45° FOV; 2048x1536 — 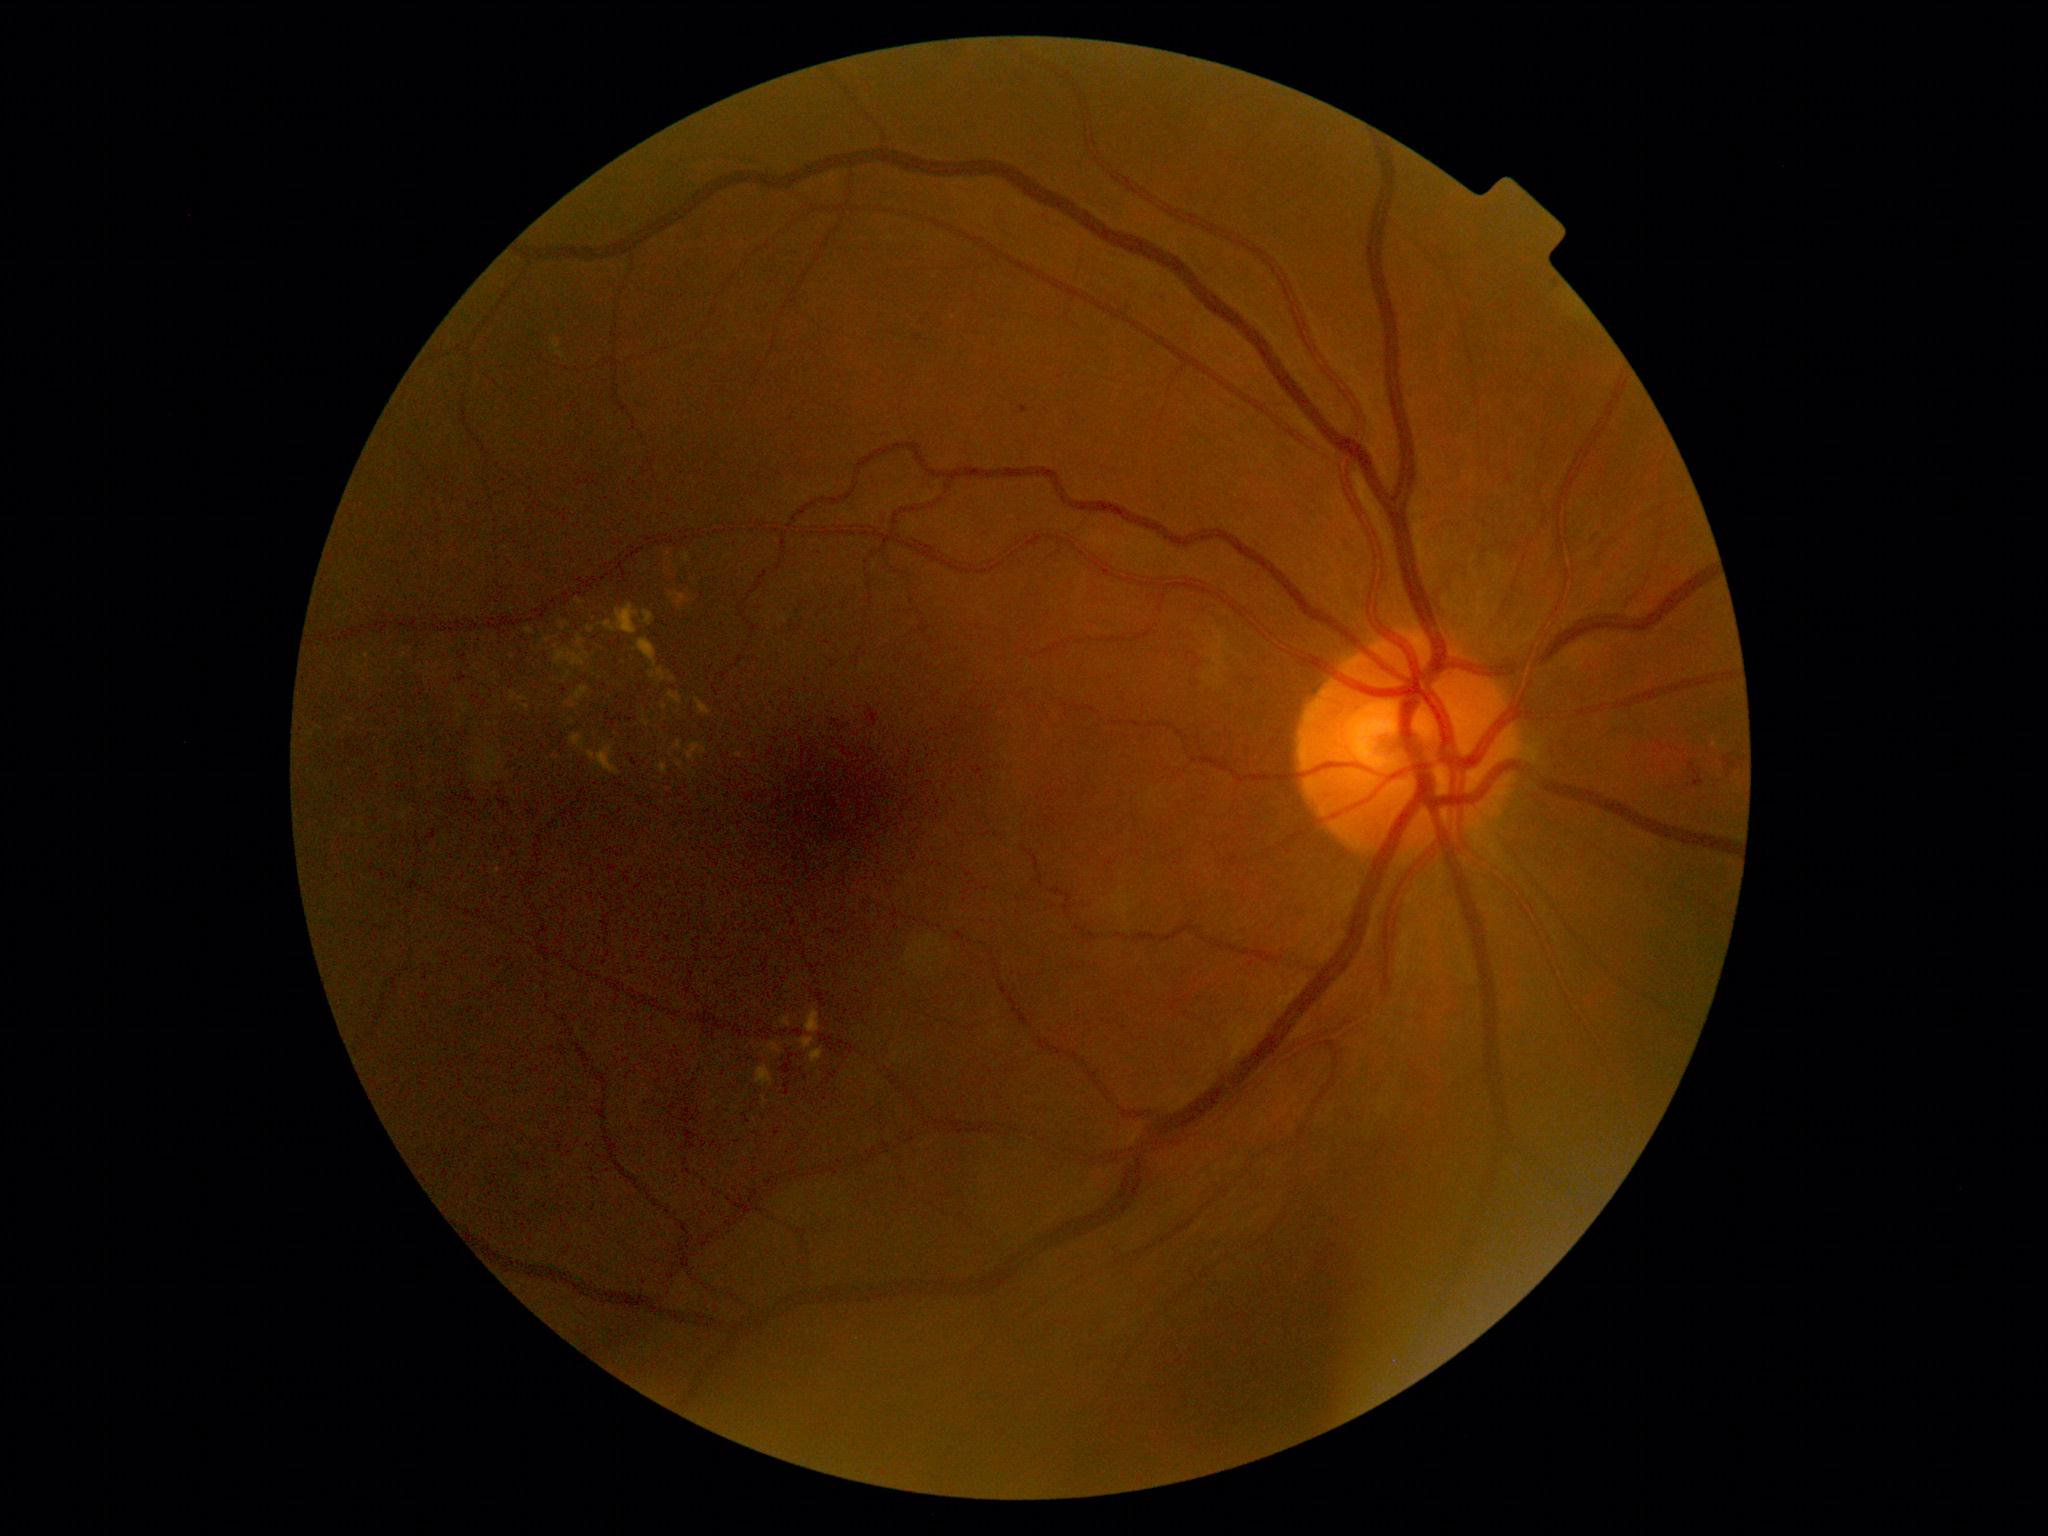 Diabetic retinopathy (DR): moderate NPDR (grade 2). The retinopathy is classified as non-proliferative diabetic retinopathy.